2228x1652px. Mydriatic (tropicamide and phenylephrine) — 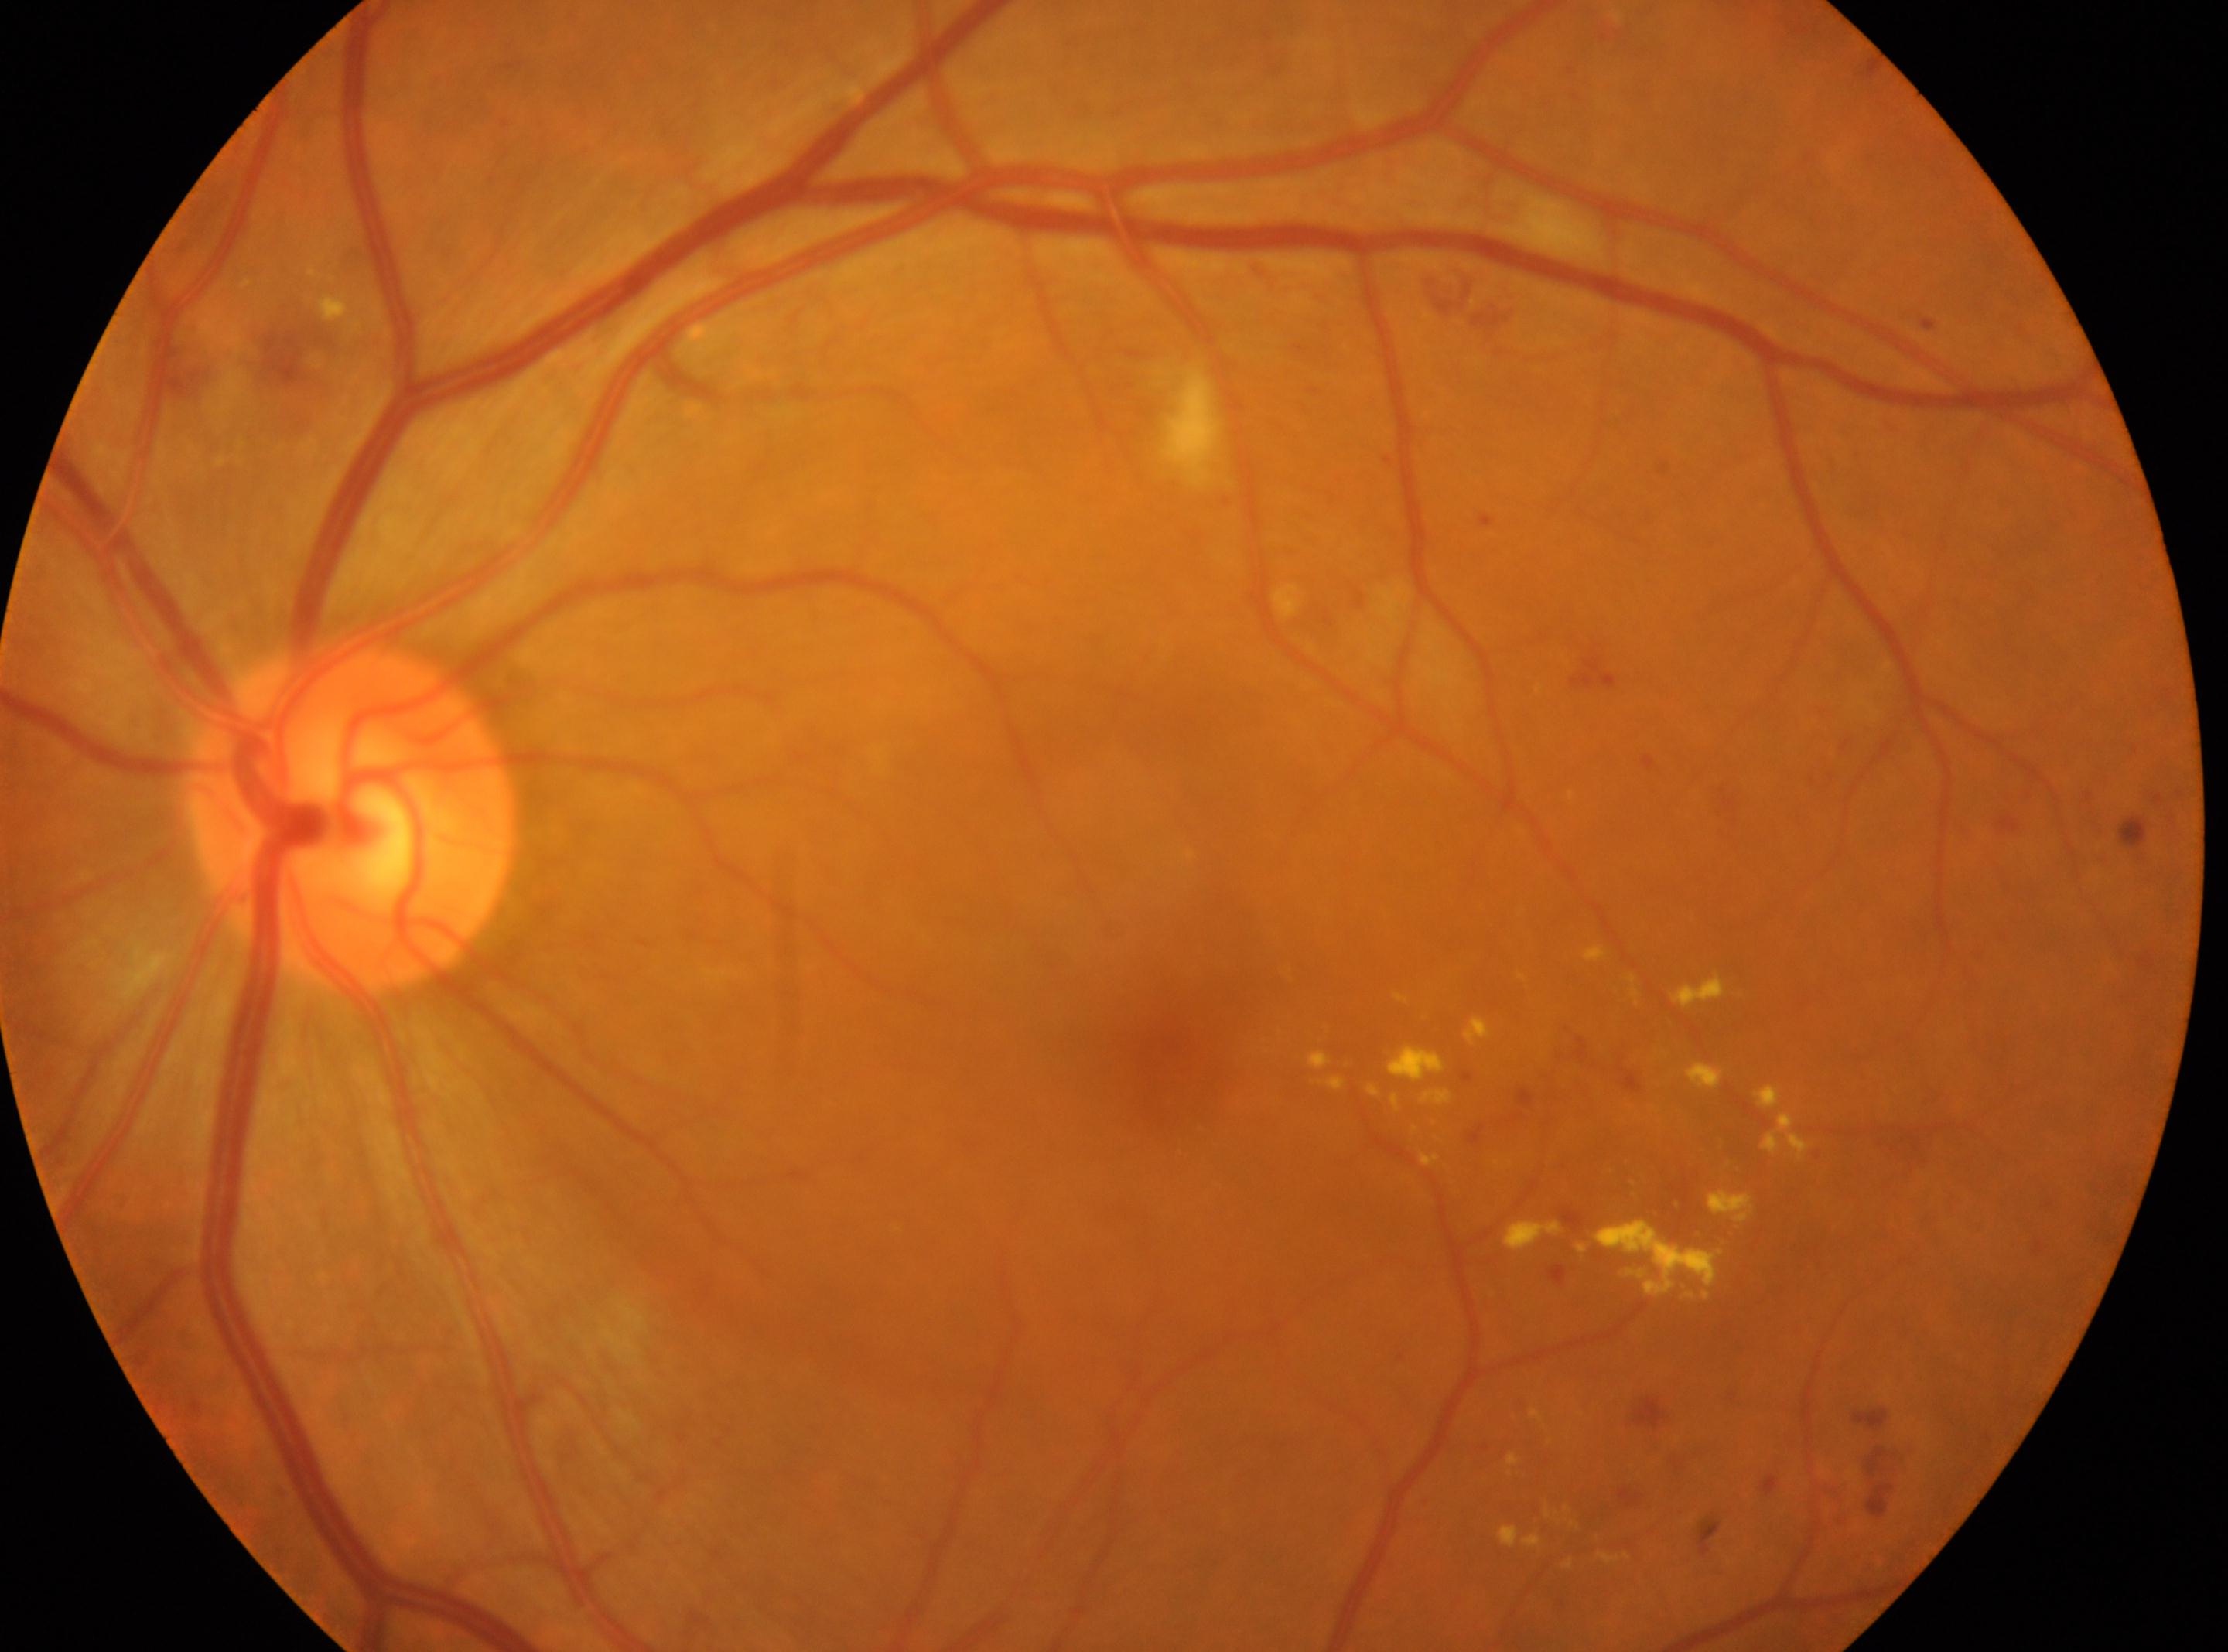

{
  "optic_disc": "(354, 817)",
  "dr_category": "non-proliferative diabetic retinopathy",
  "dr_grade": "moderate NPDR (2)",
  "fovea": "(1174, 1061)",
  "eye": "left eye"
}